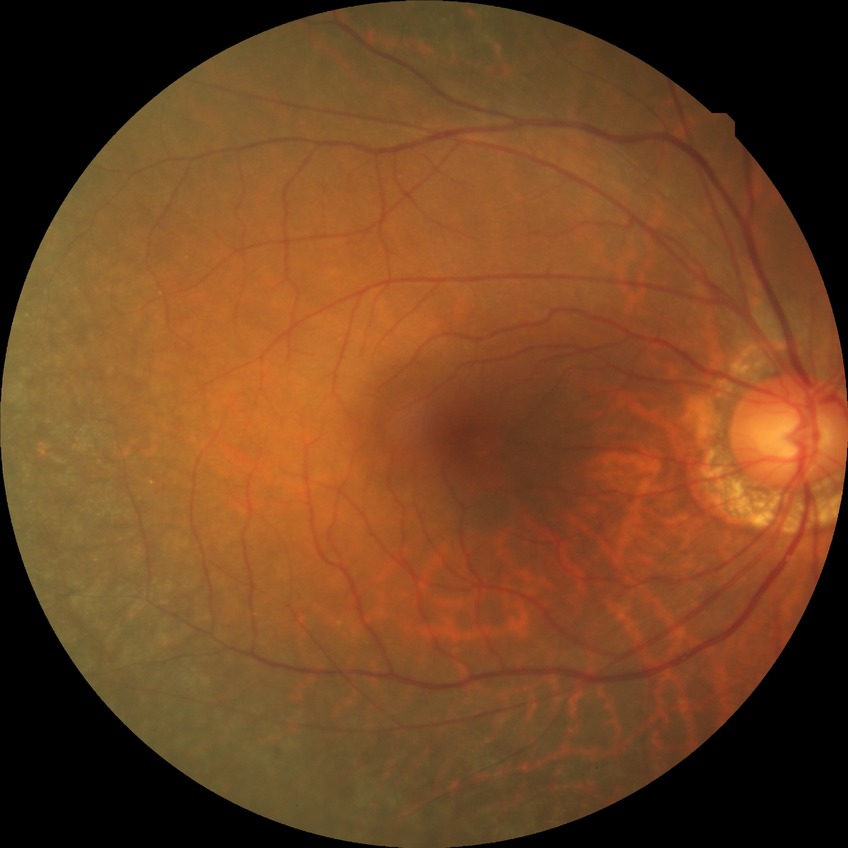 Diabetic retinopathy (DR): no diabetic retinopathy (NDR).